Clarity RetCam 3, 130° FOV; wide-field fundus photograph of an infant.
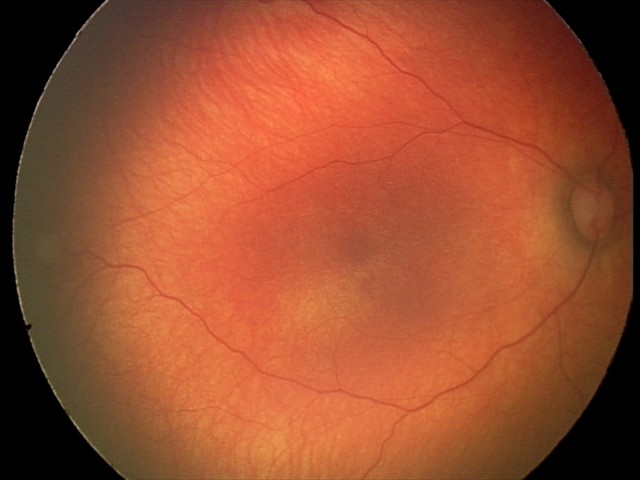

Q: What is the diagnosis from this examination?
A: physiological finding